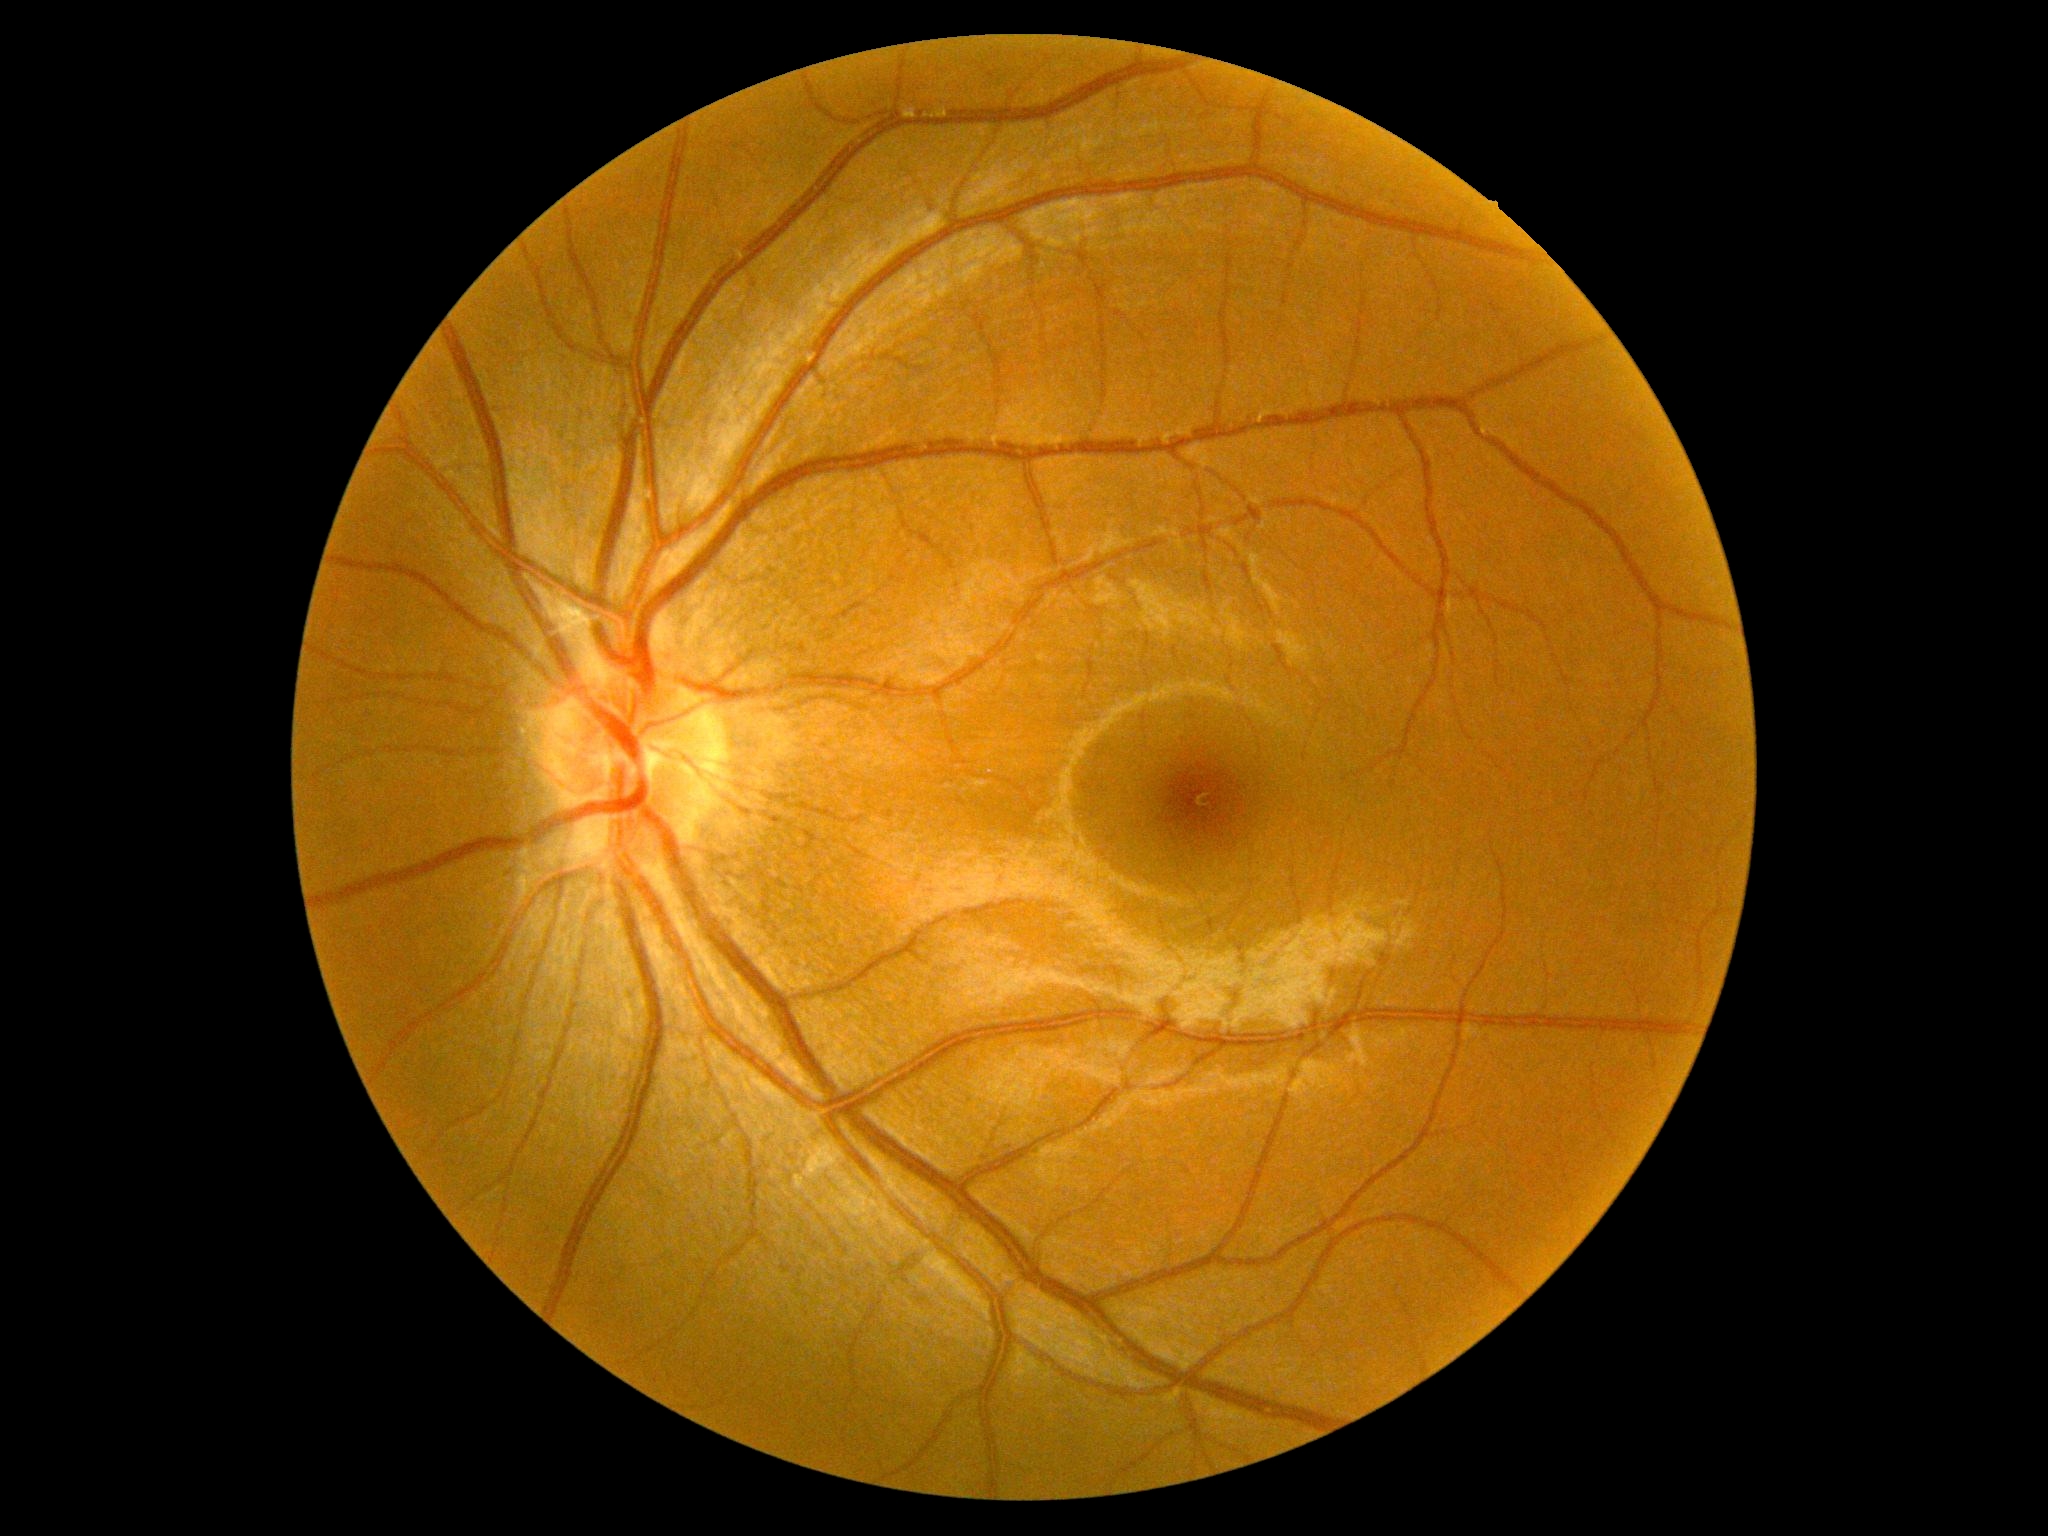
DR severity: no apparent diabetic retinopathy (grade 0).